Wide-field fundus image from infant ROP screening. 1240x1240
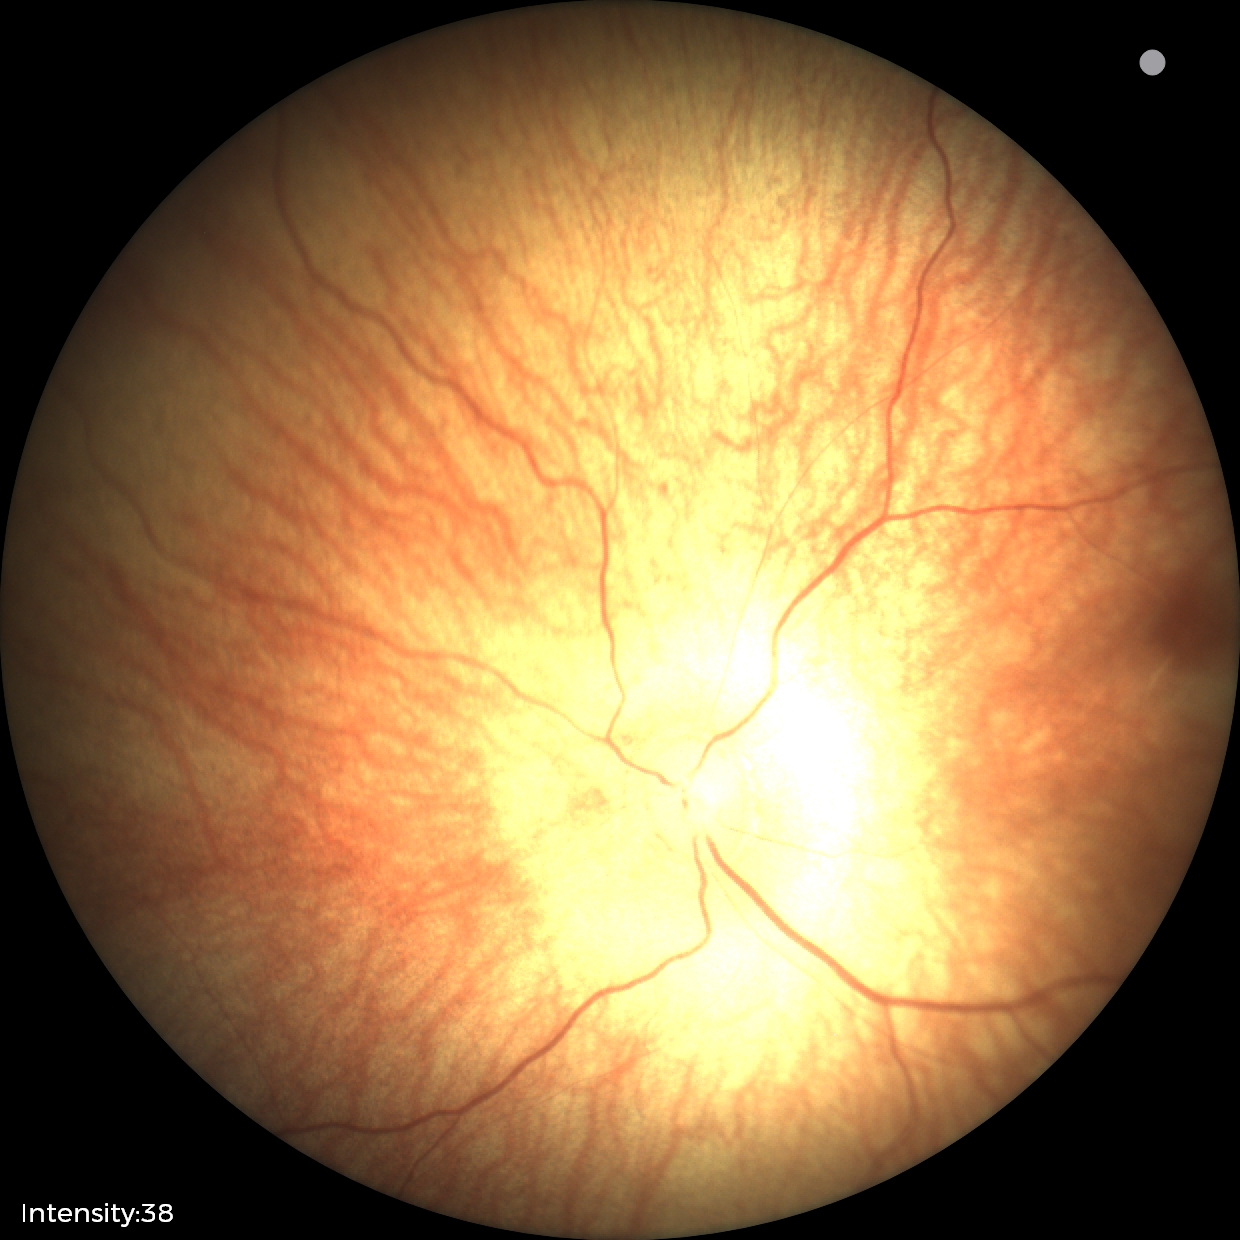

Diagnosis = normal